Fundus photo
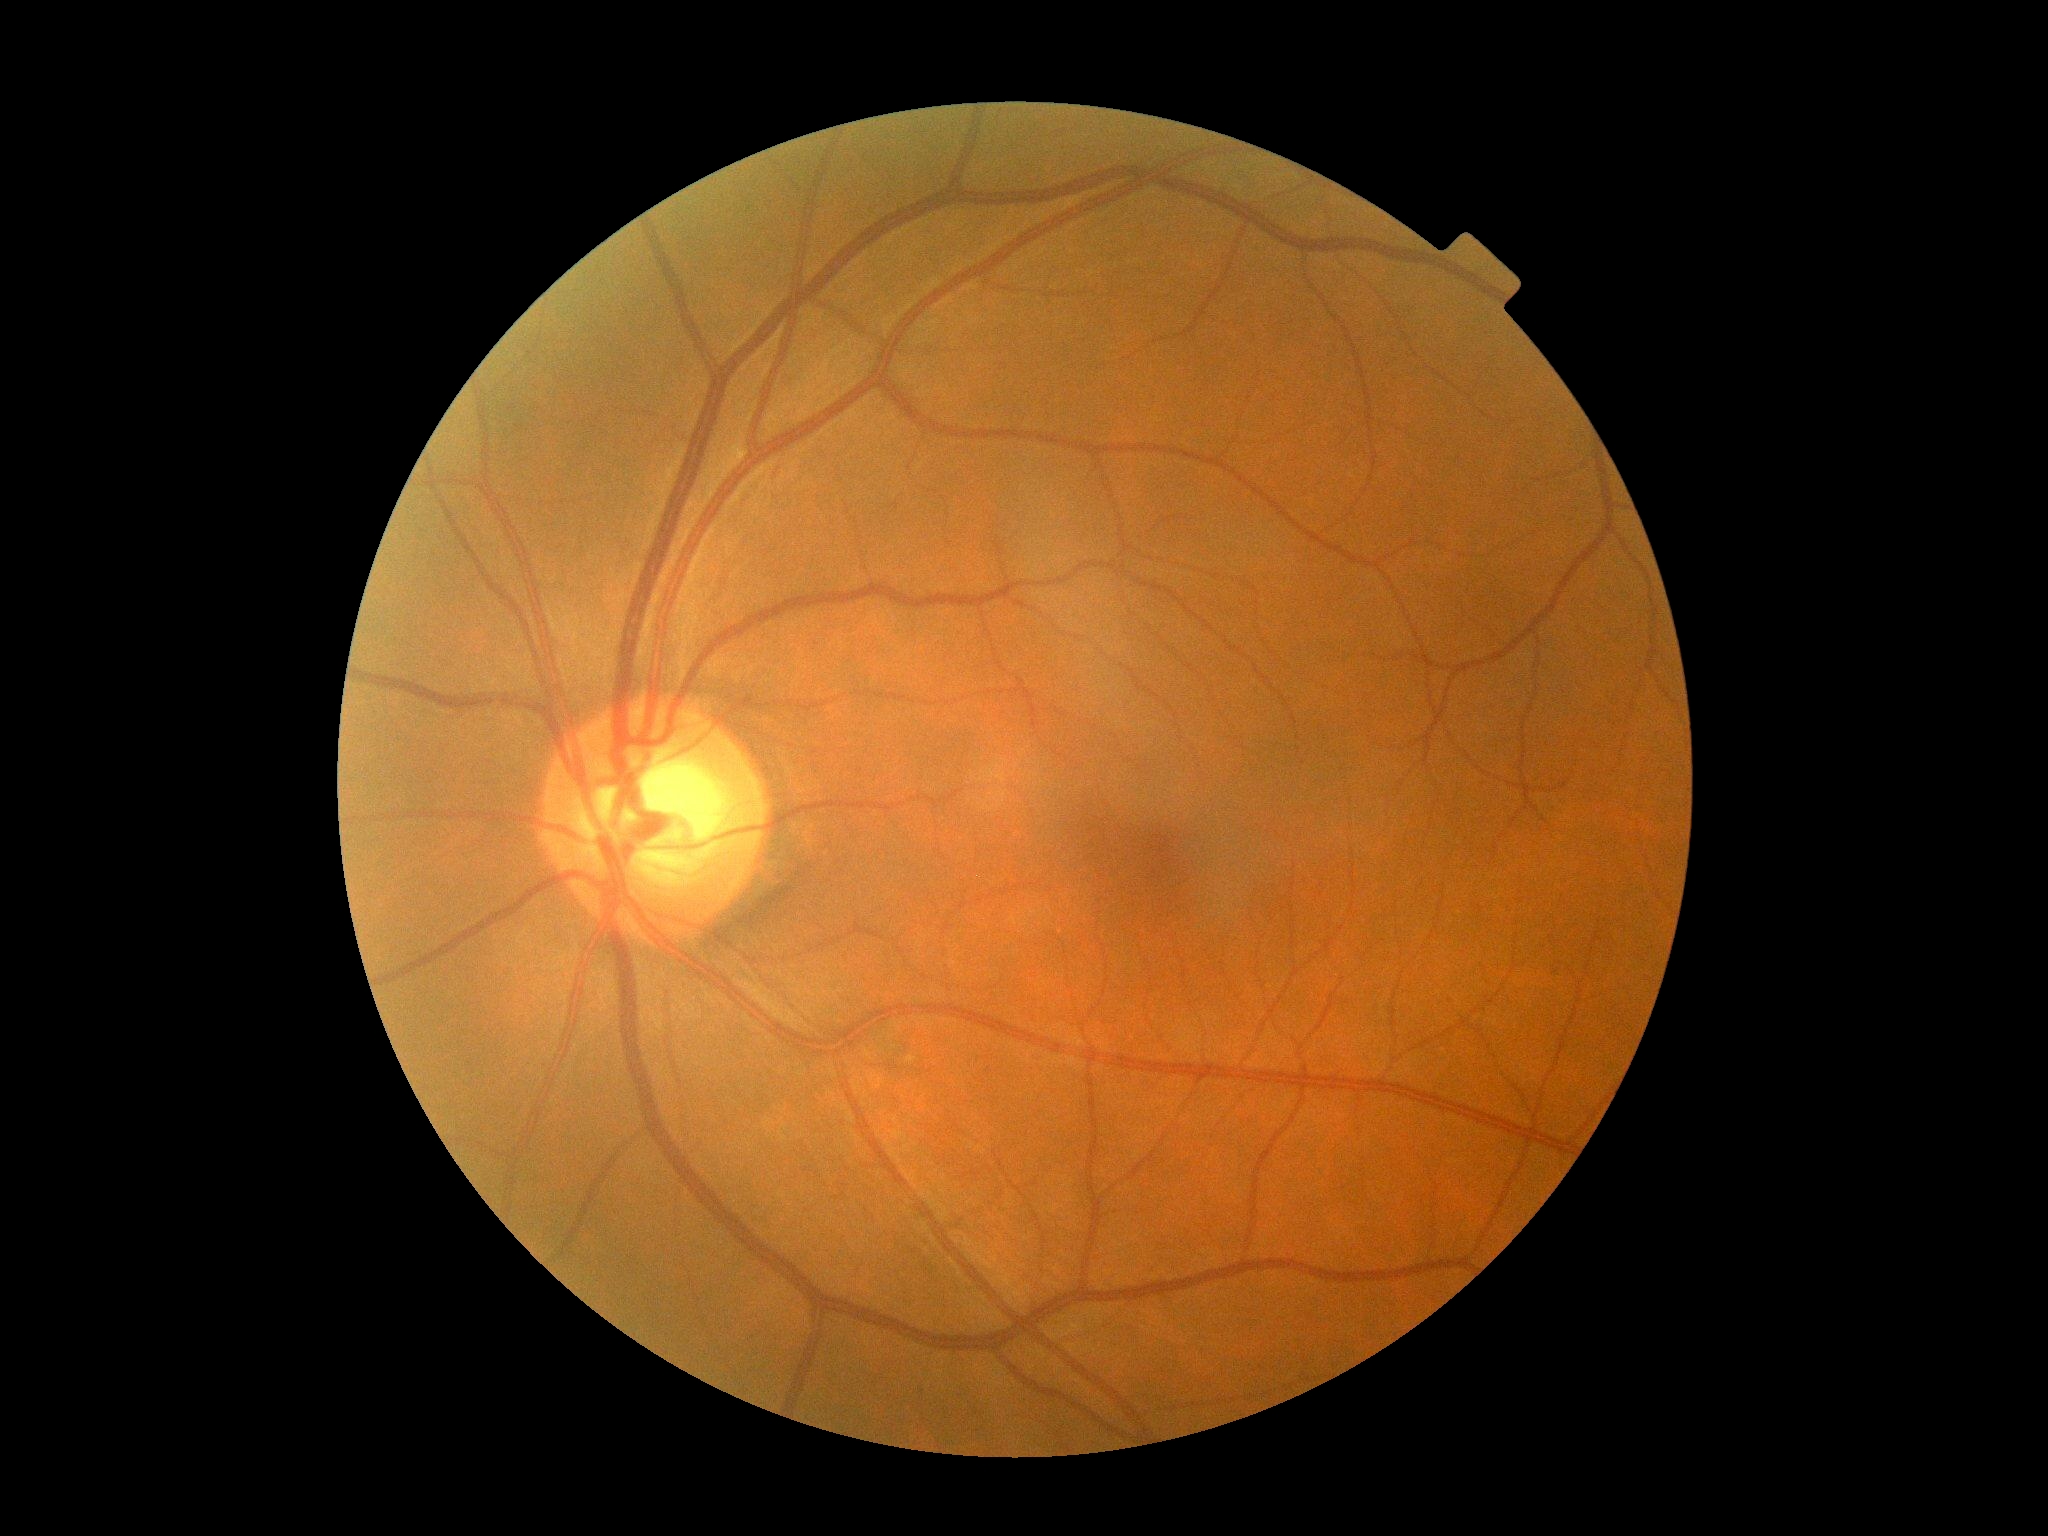 {"dr_grade": "grade 0", "dr_impression": "no DR findings"}